Refractive error: +1.75 -0.25 × 110°. Axial length (AL) 22.71 mm. Corneal thickness 479 µm:
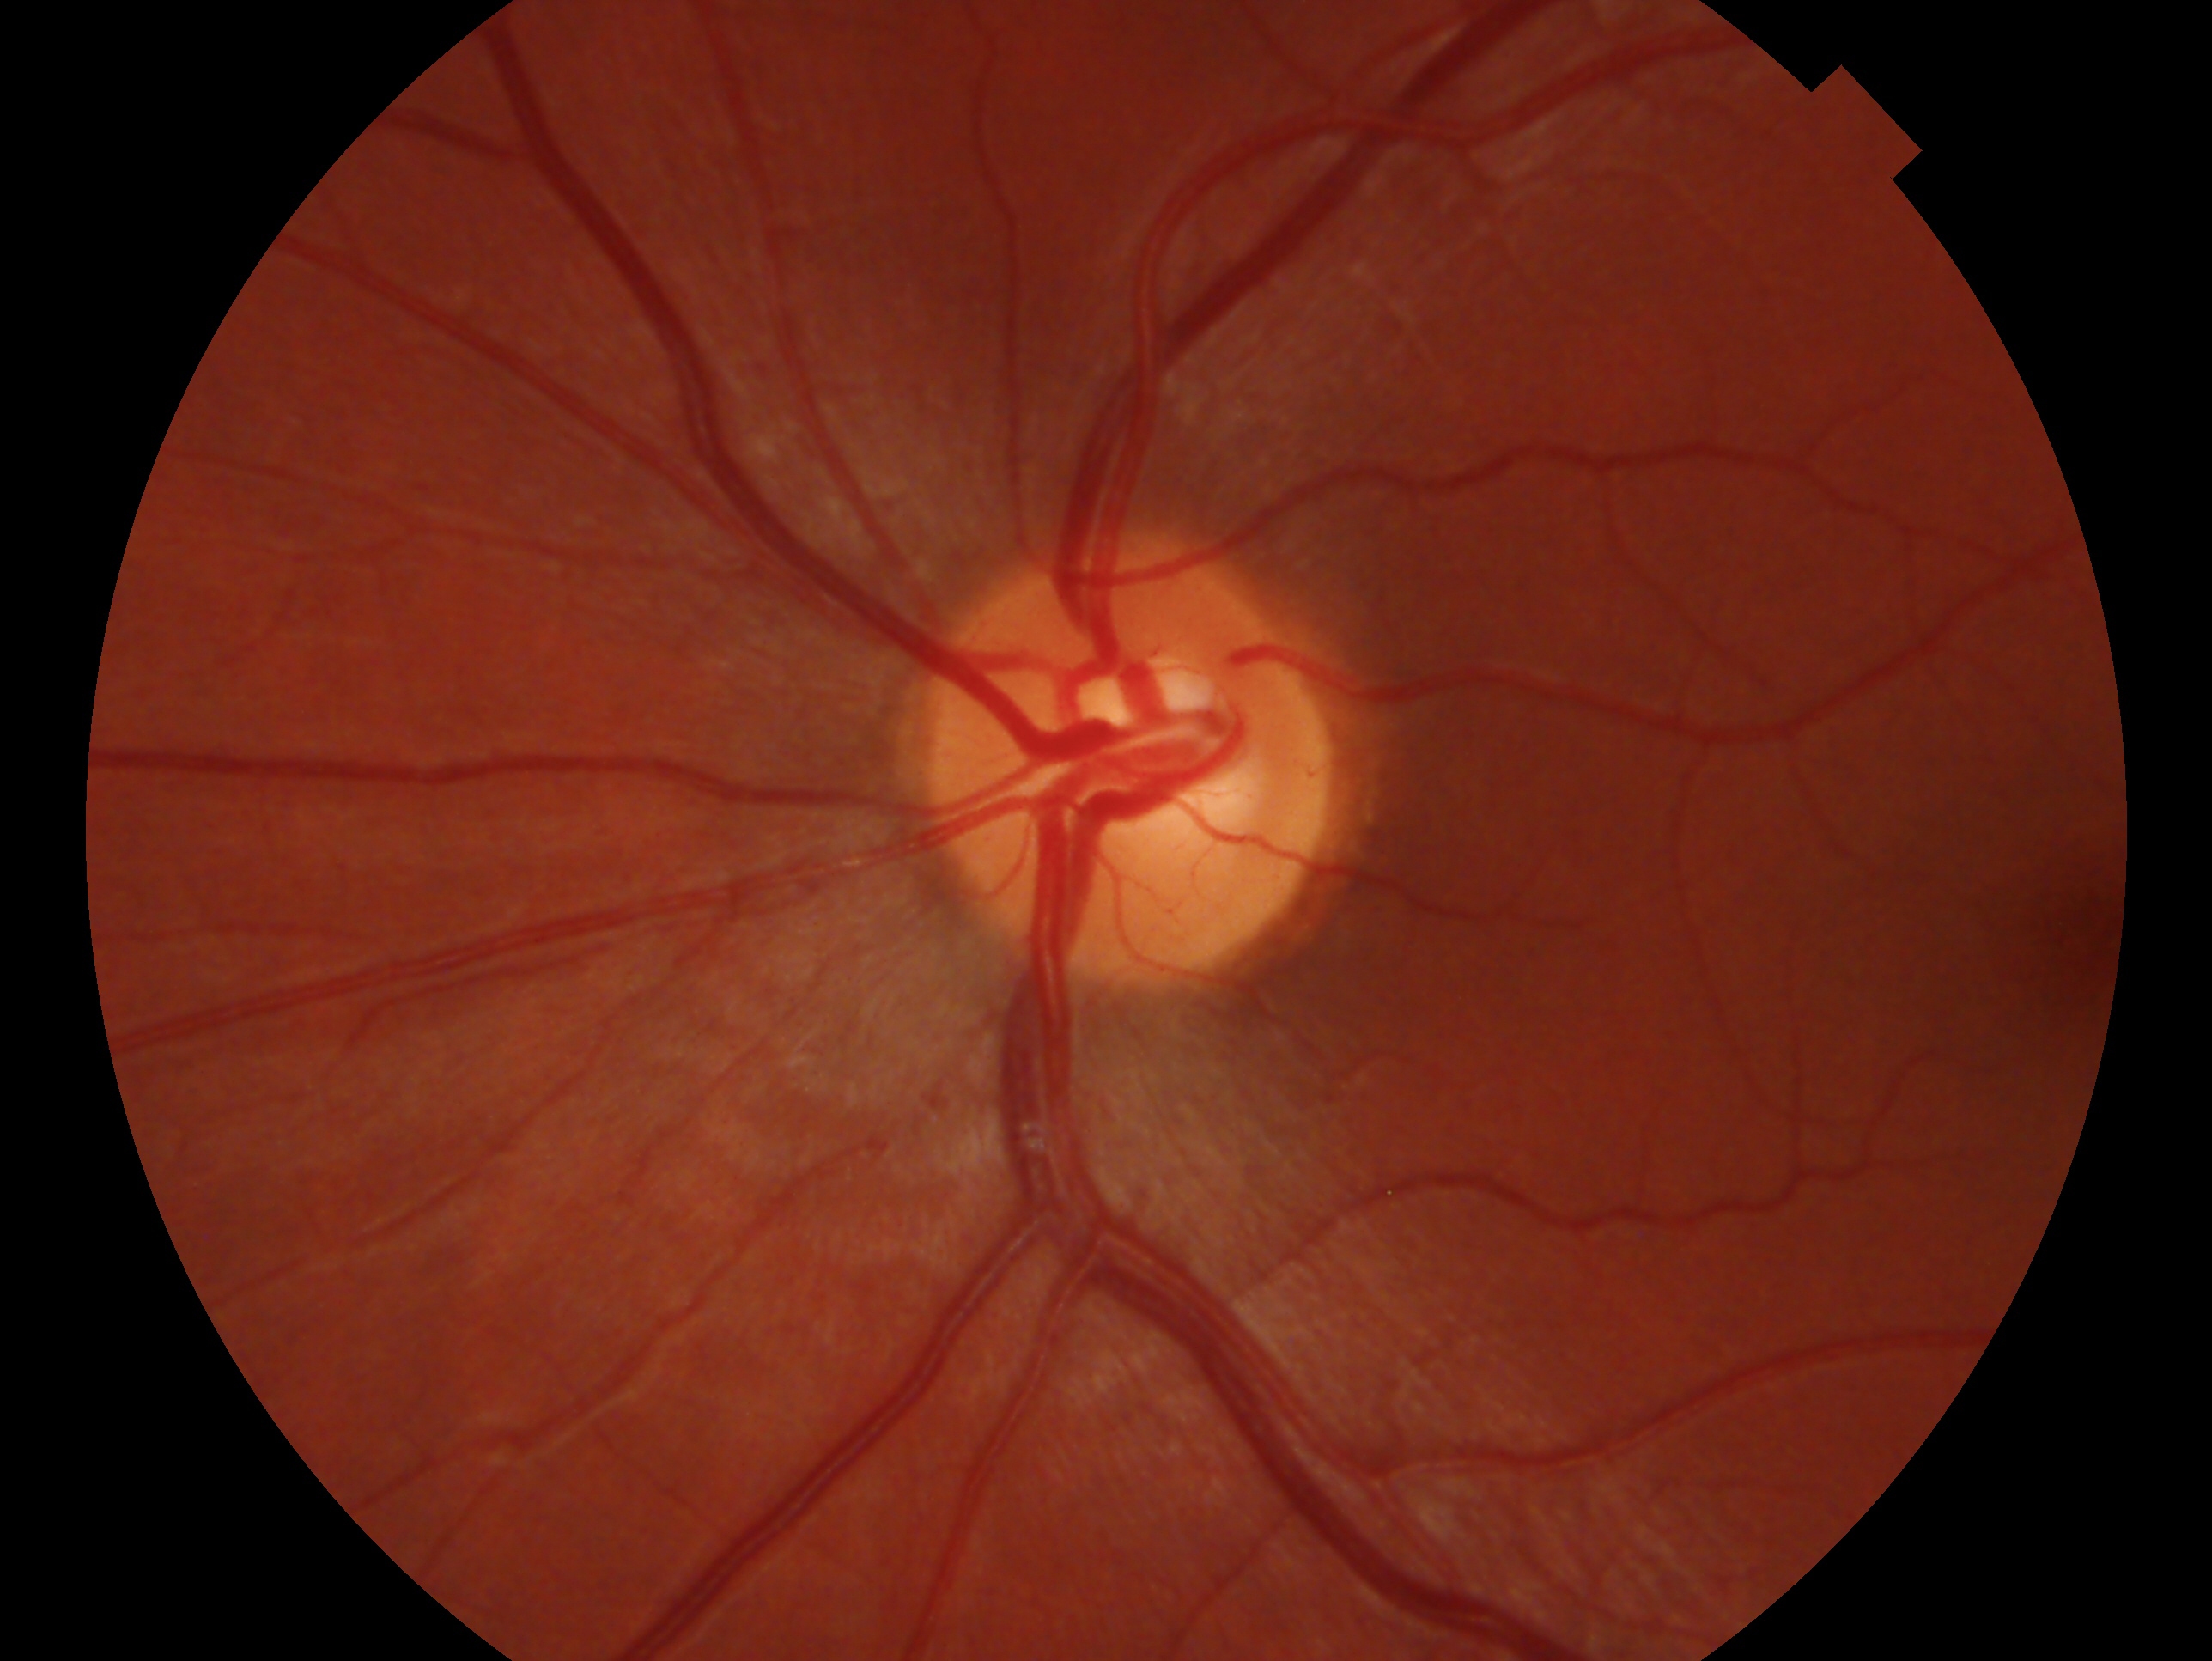 Impression: negative for glaucoma. This is the left eye.